Image size 1380x1382, 45-degree field of view — 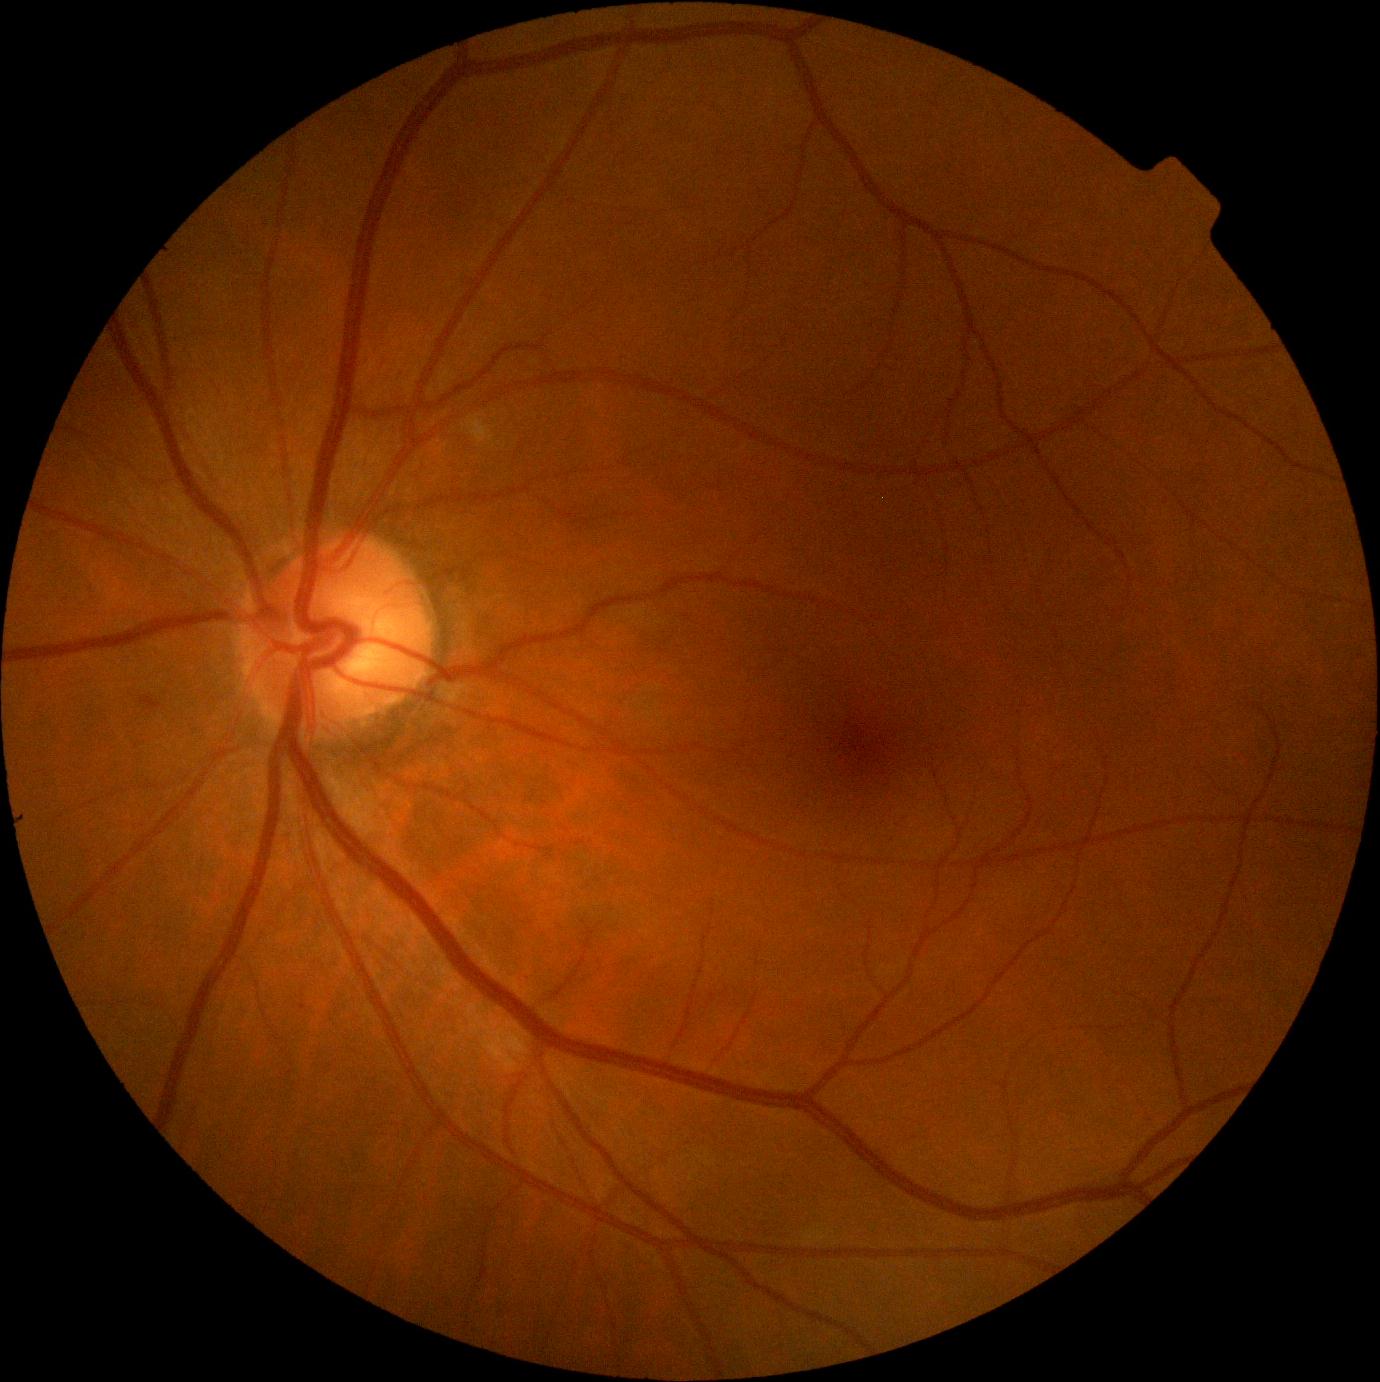 diabetic retinopathy (DR)@moderate NPDR (grade 2).